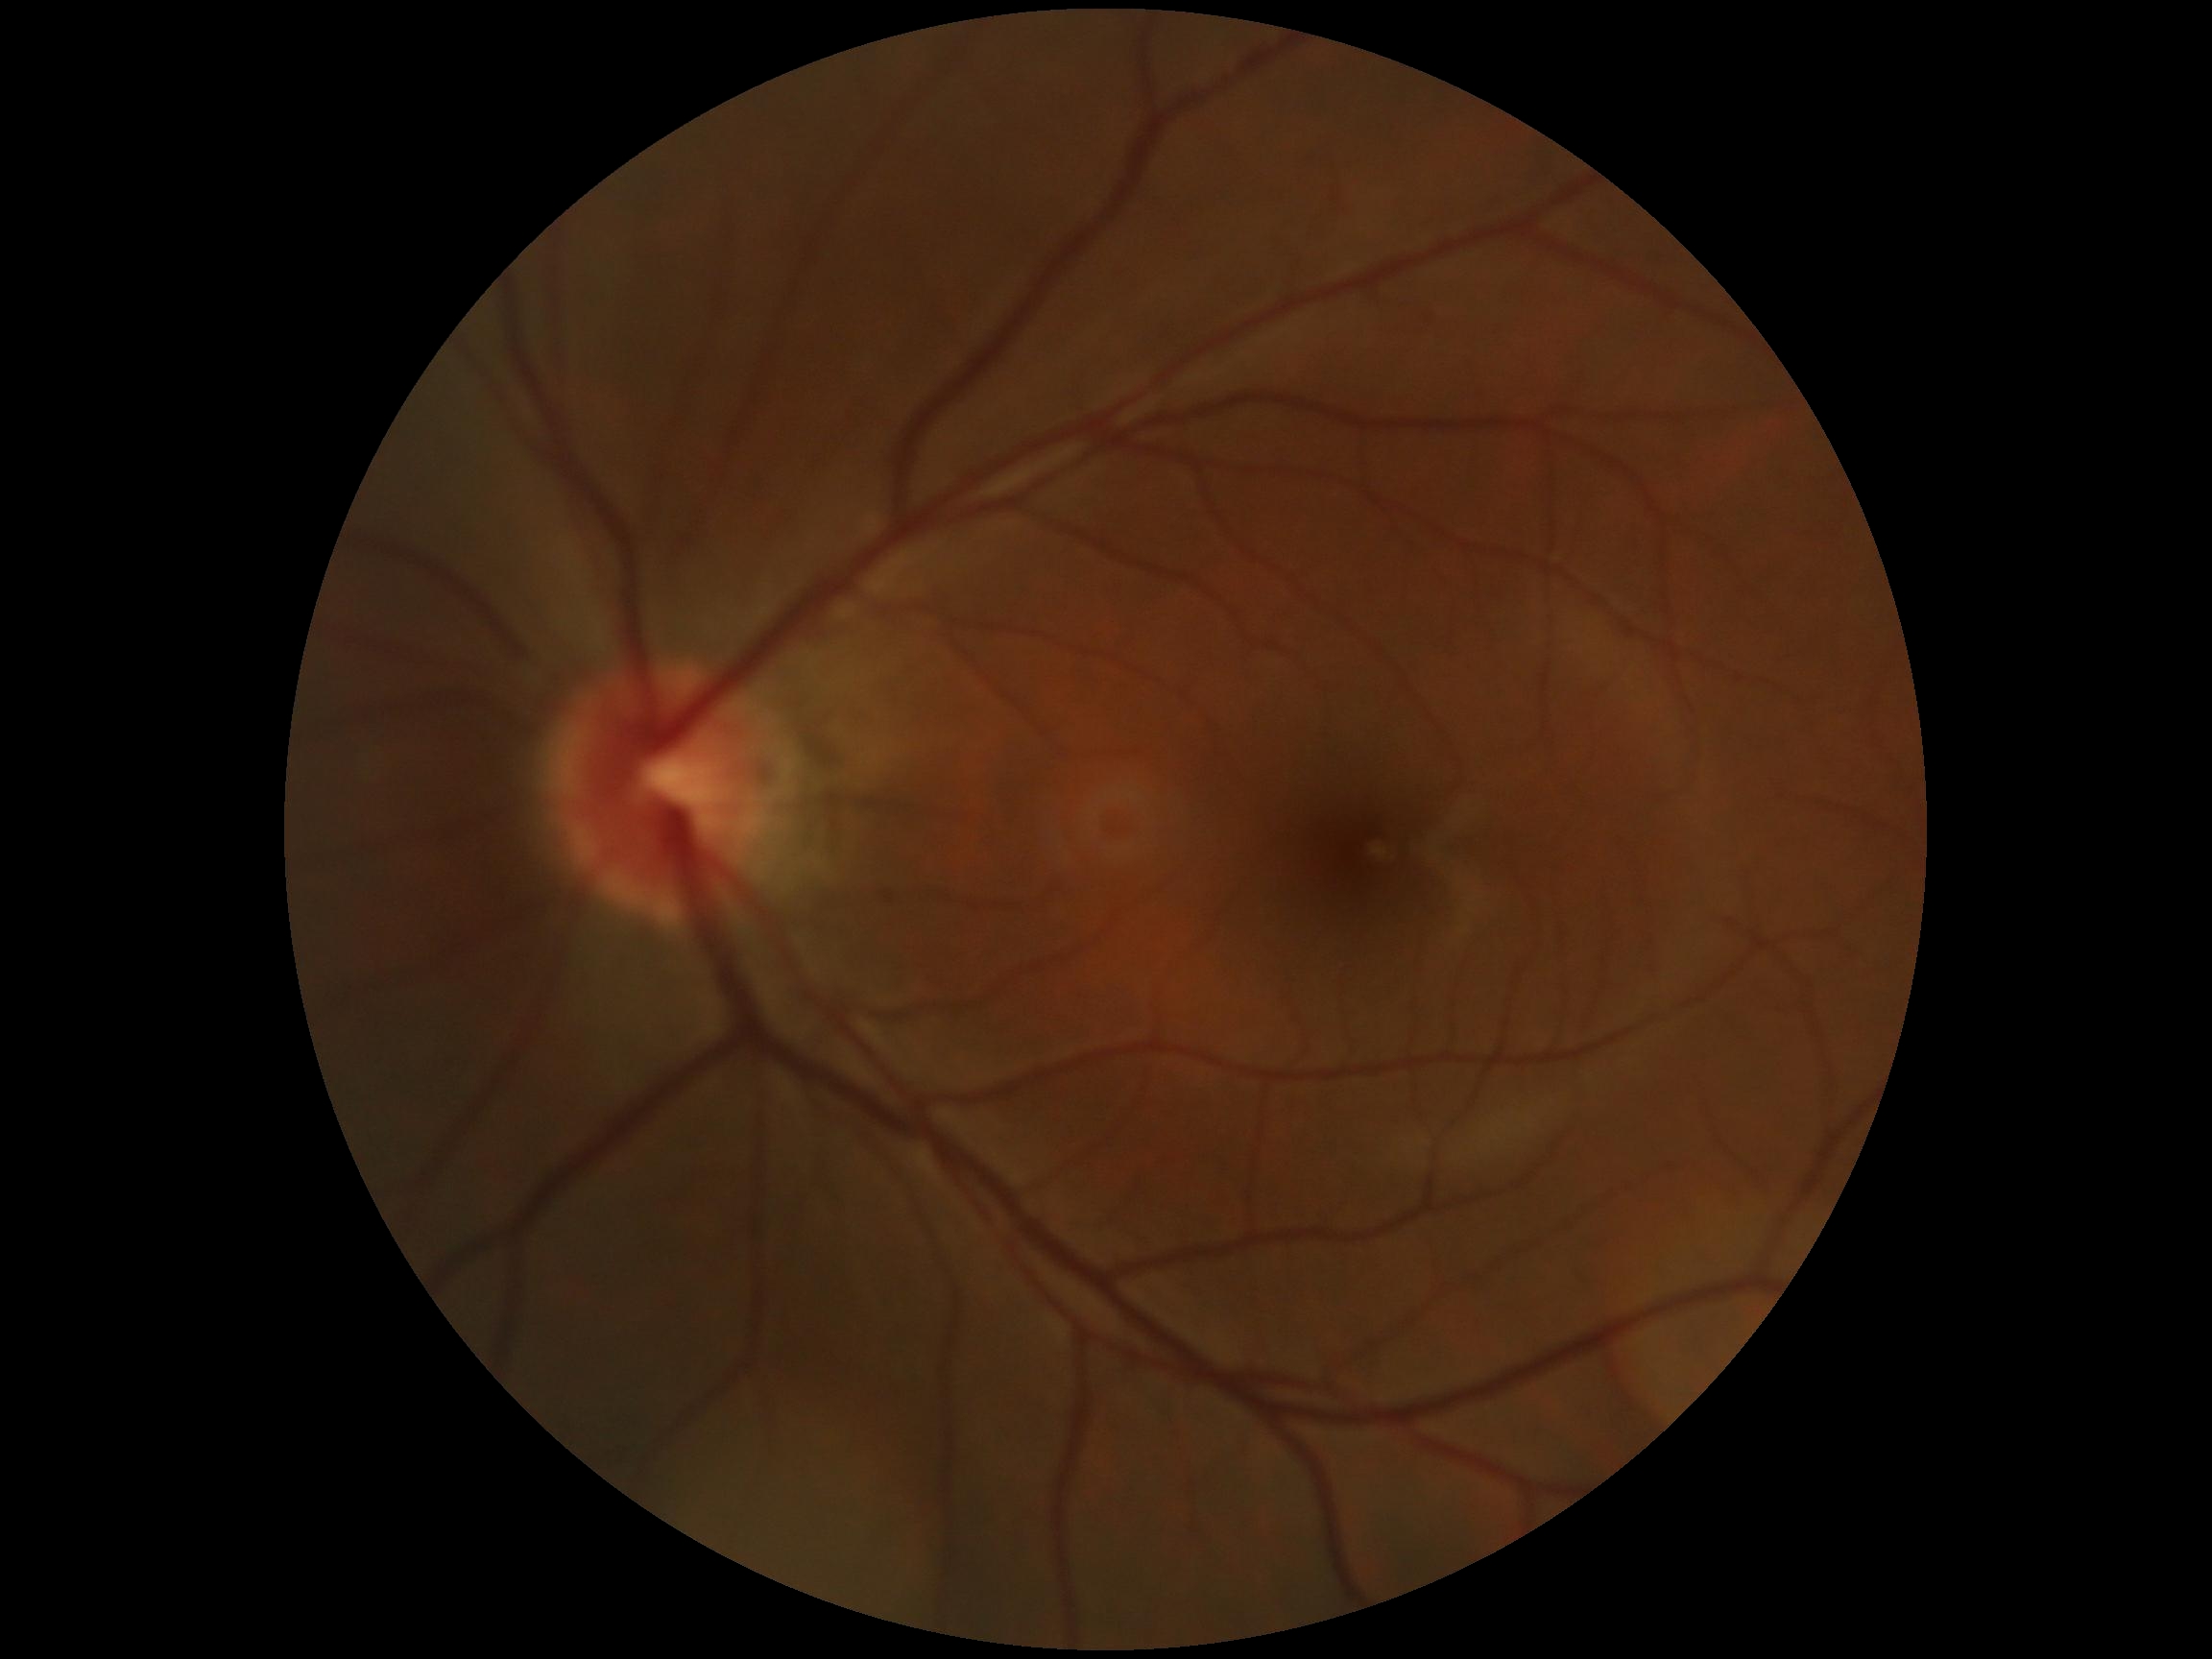 Diabetic retinopathy is no apparent retinopathy (grade 0).